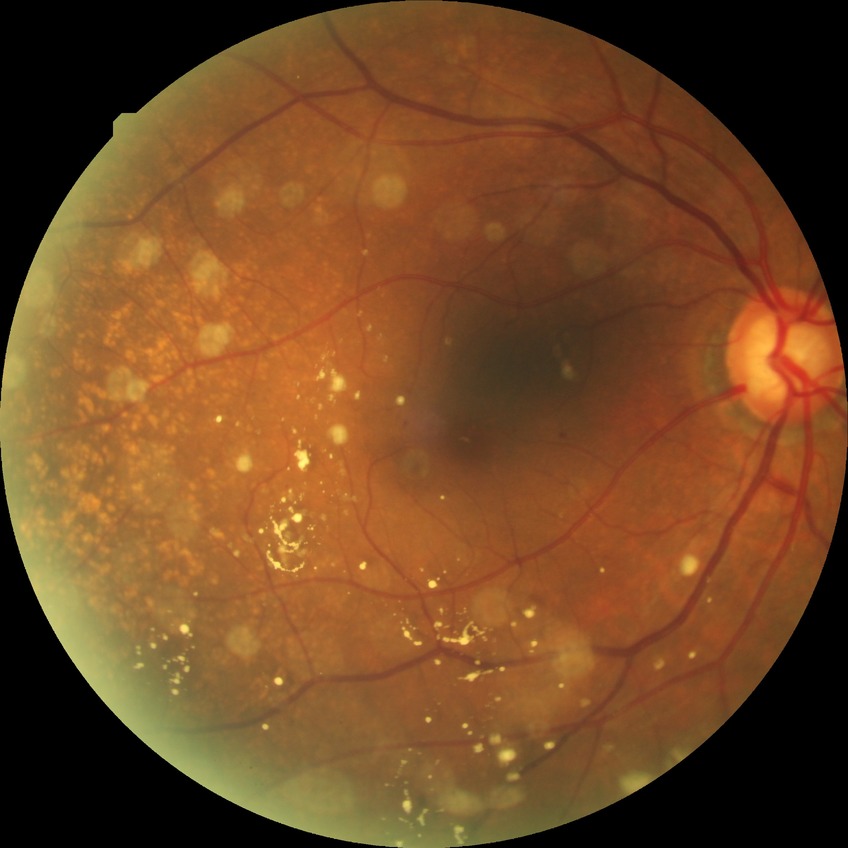
Modified Davis grade is SDR.